Pediatric wide-field fundus photograph.
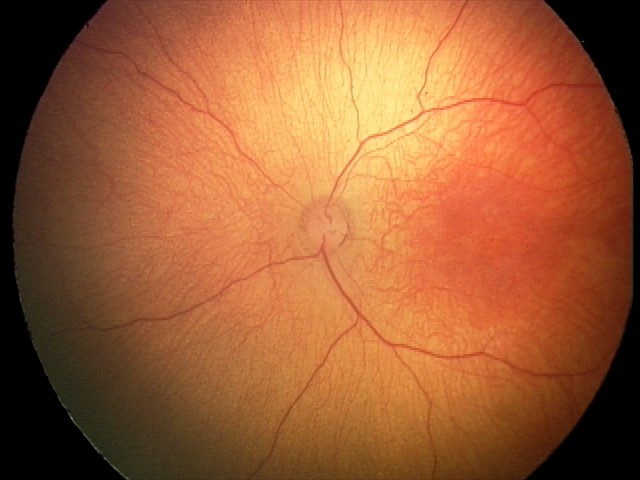

No retinal pathology identified on screening.